Color fundus photograph:
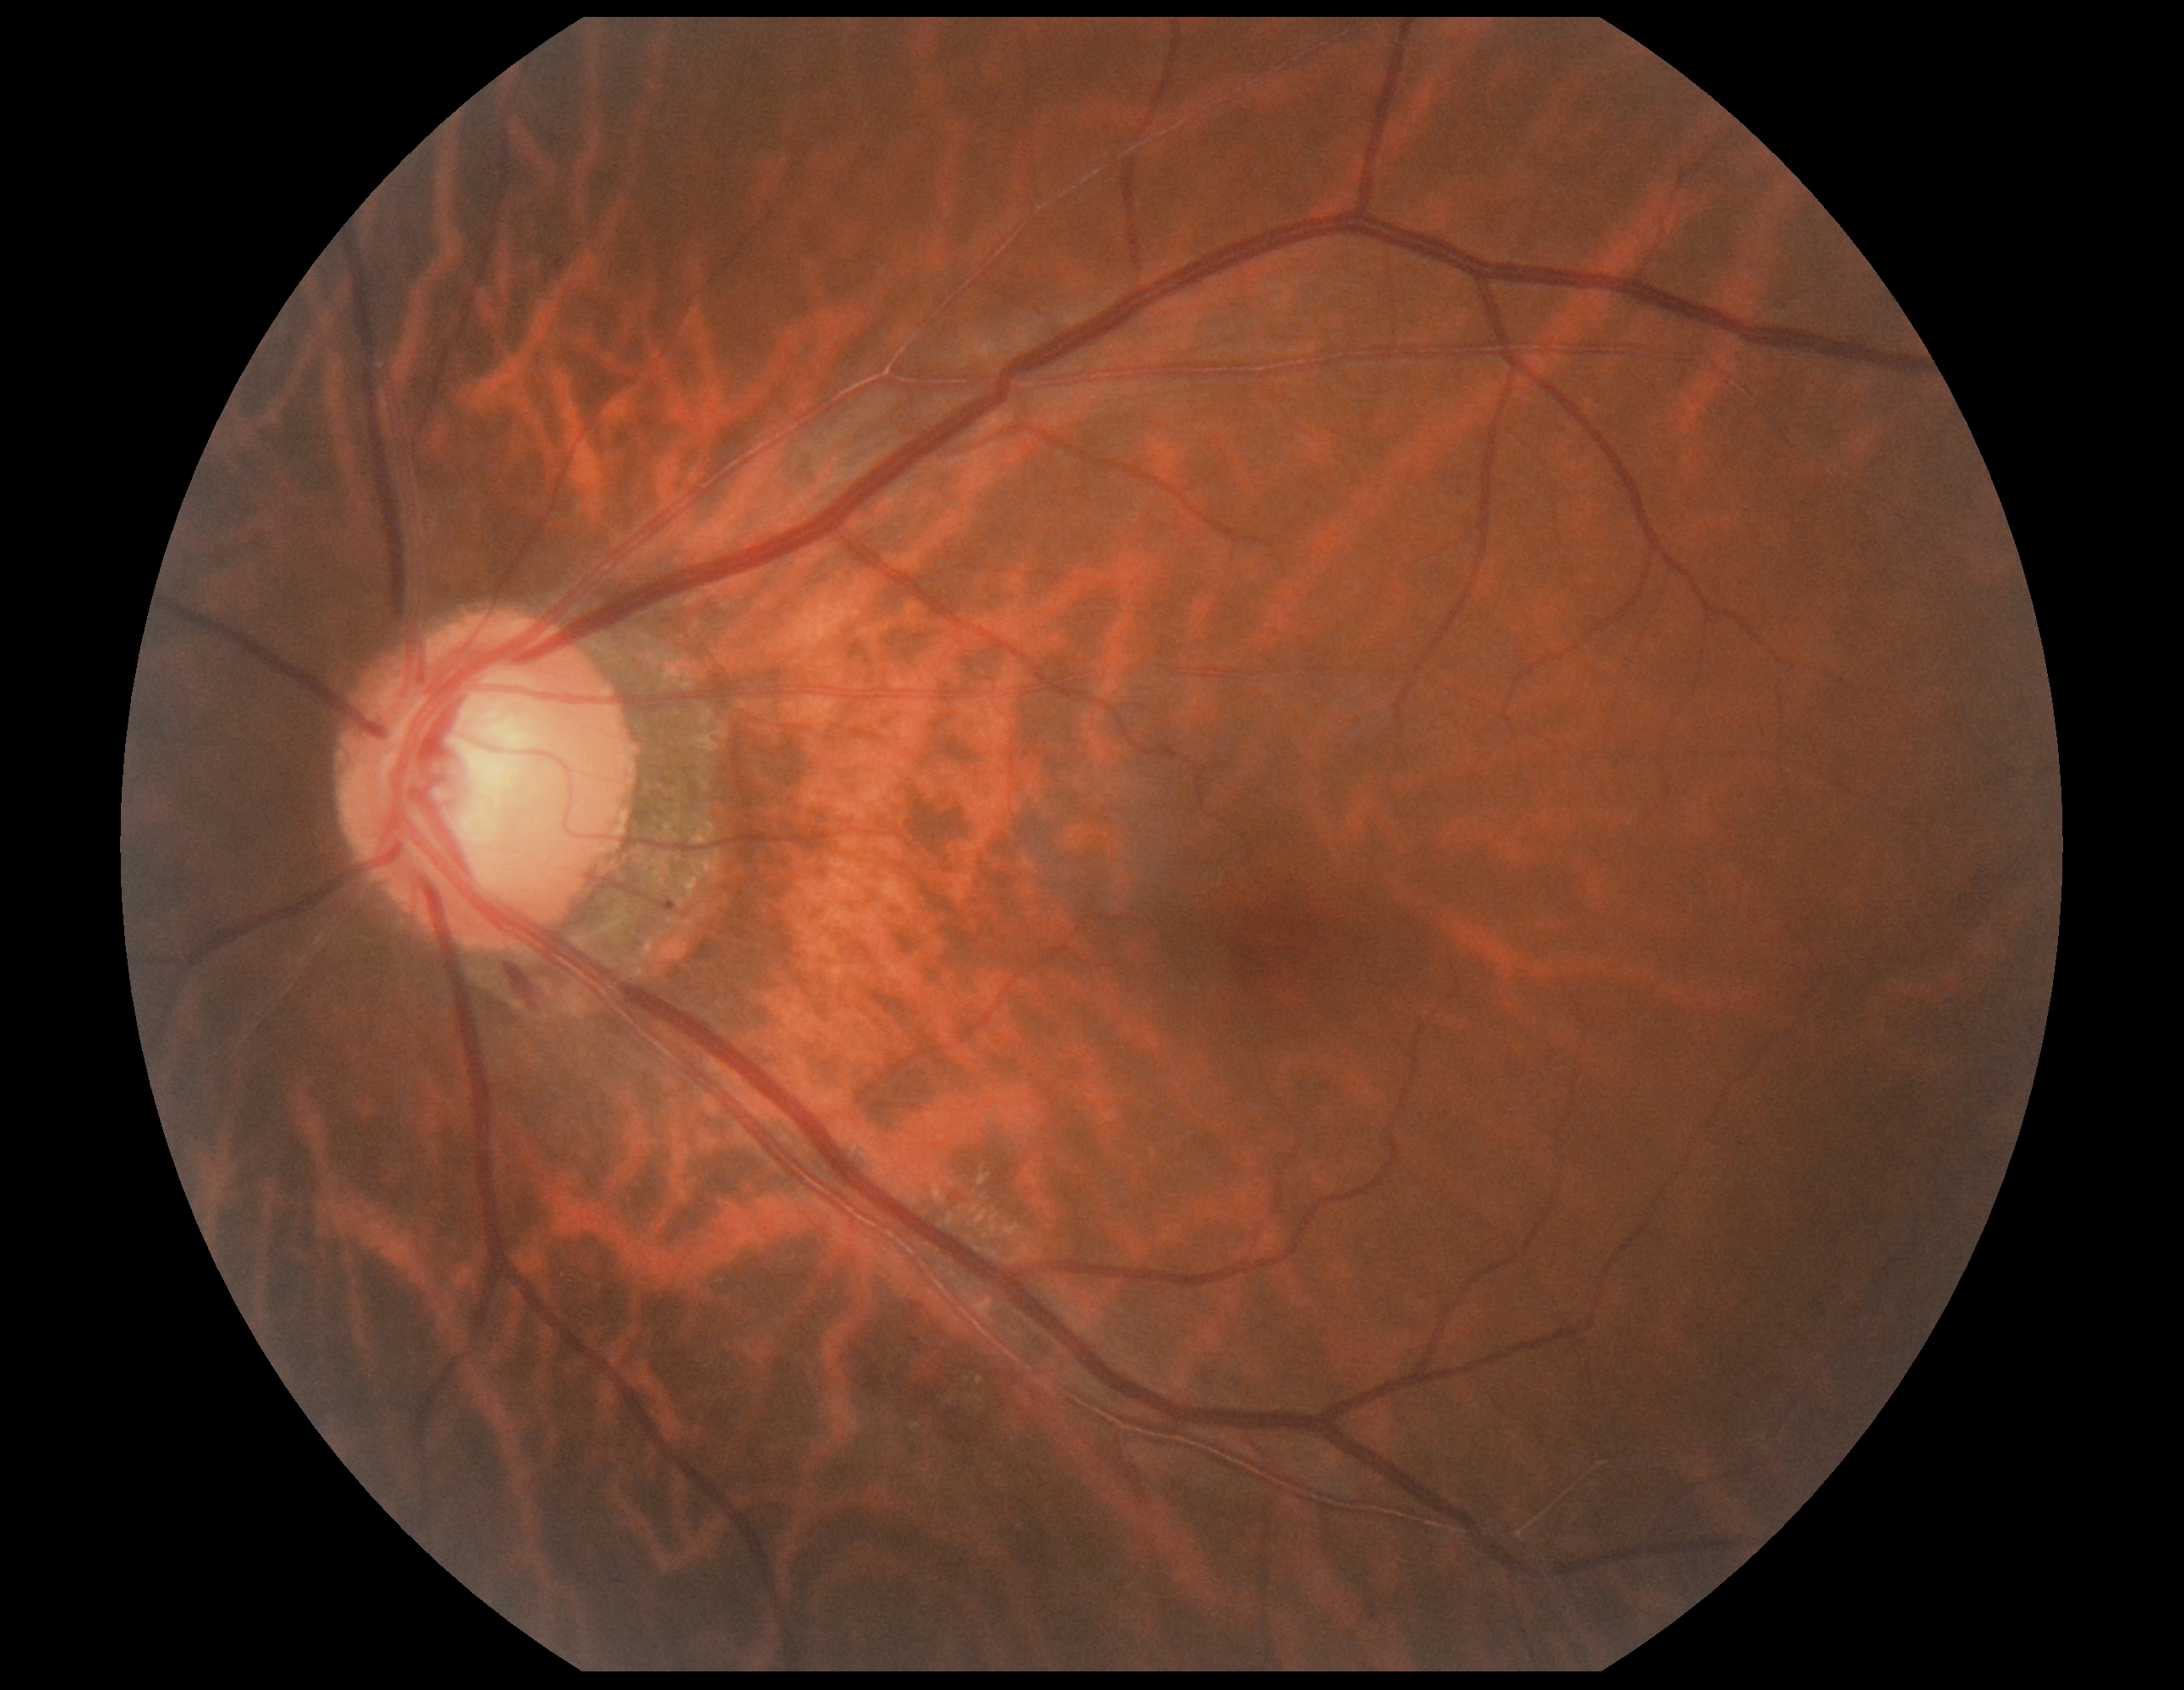
Diabetic retinopathy (DR): moderate NPDR (grade 2).